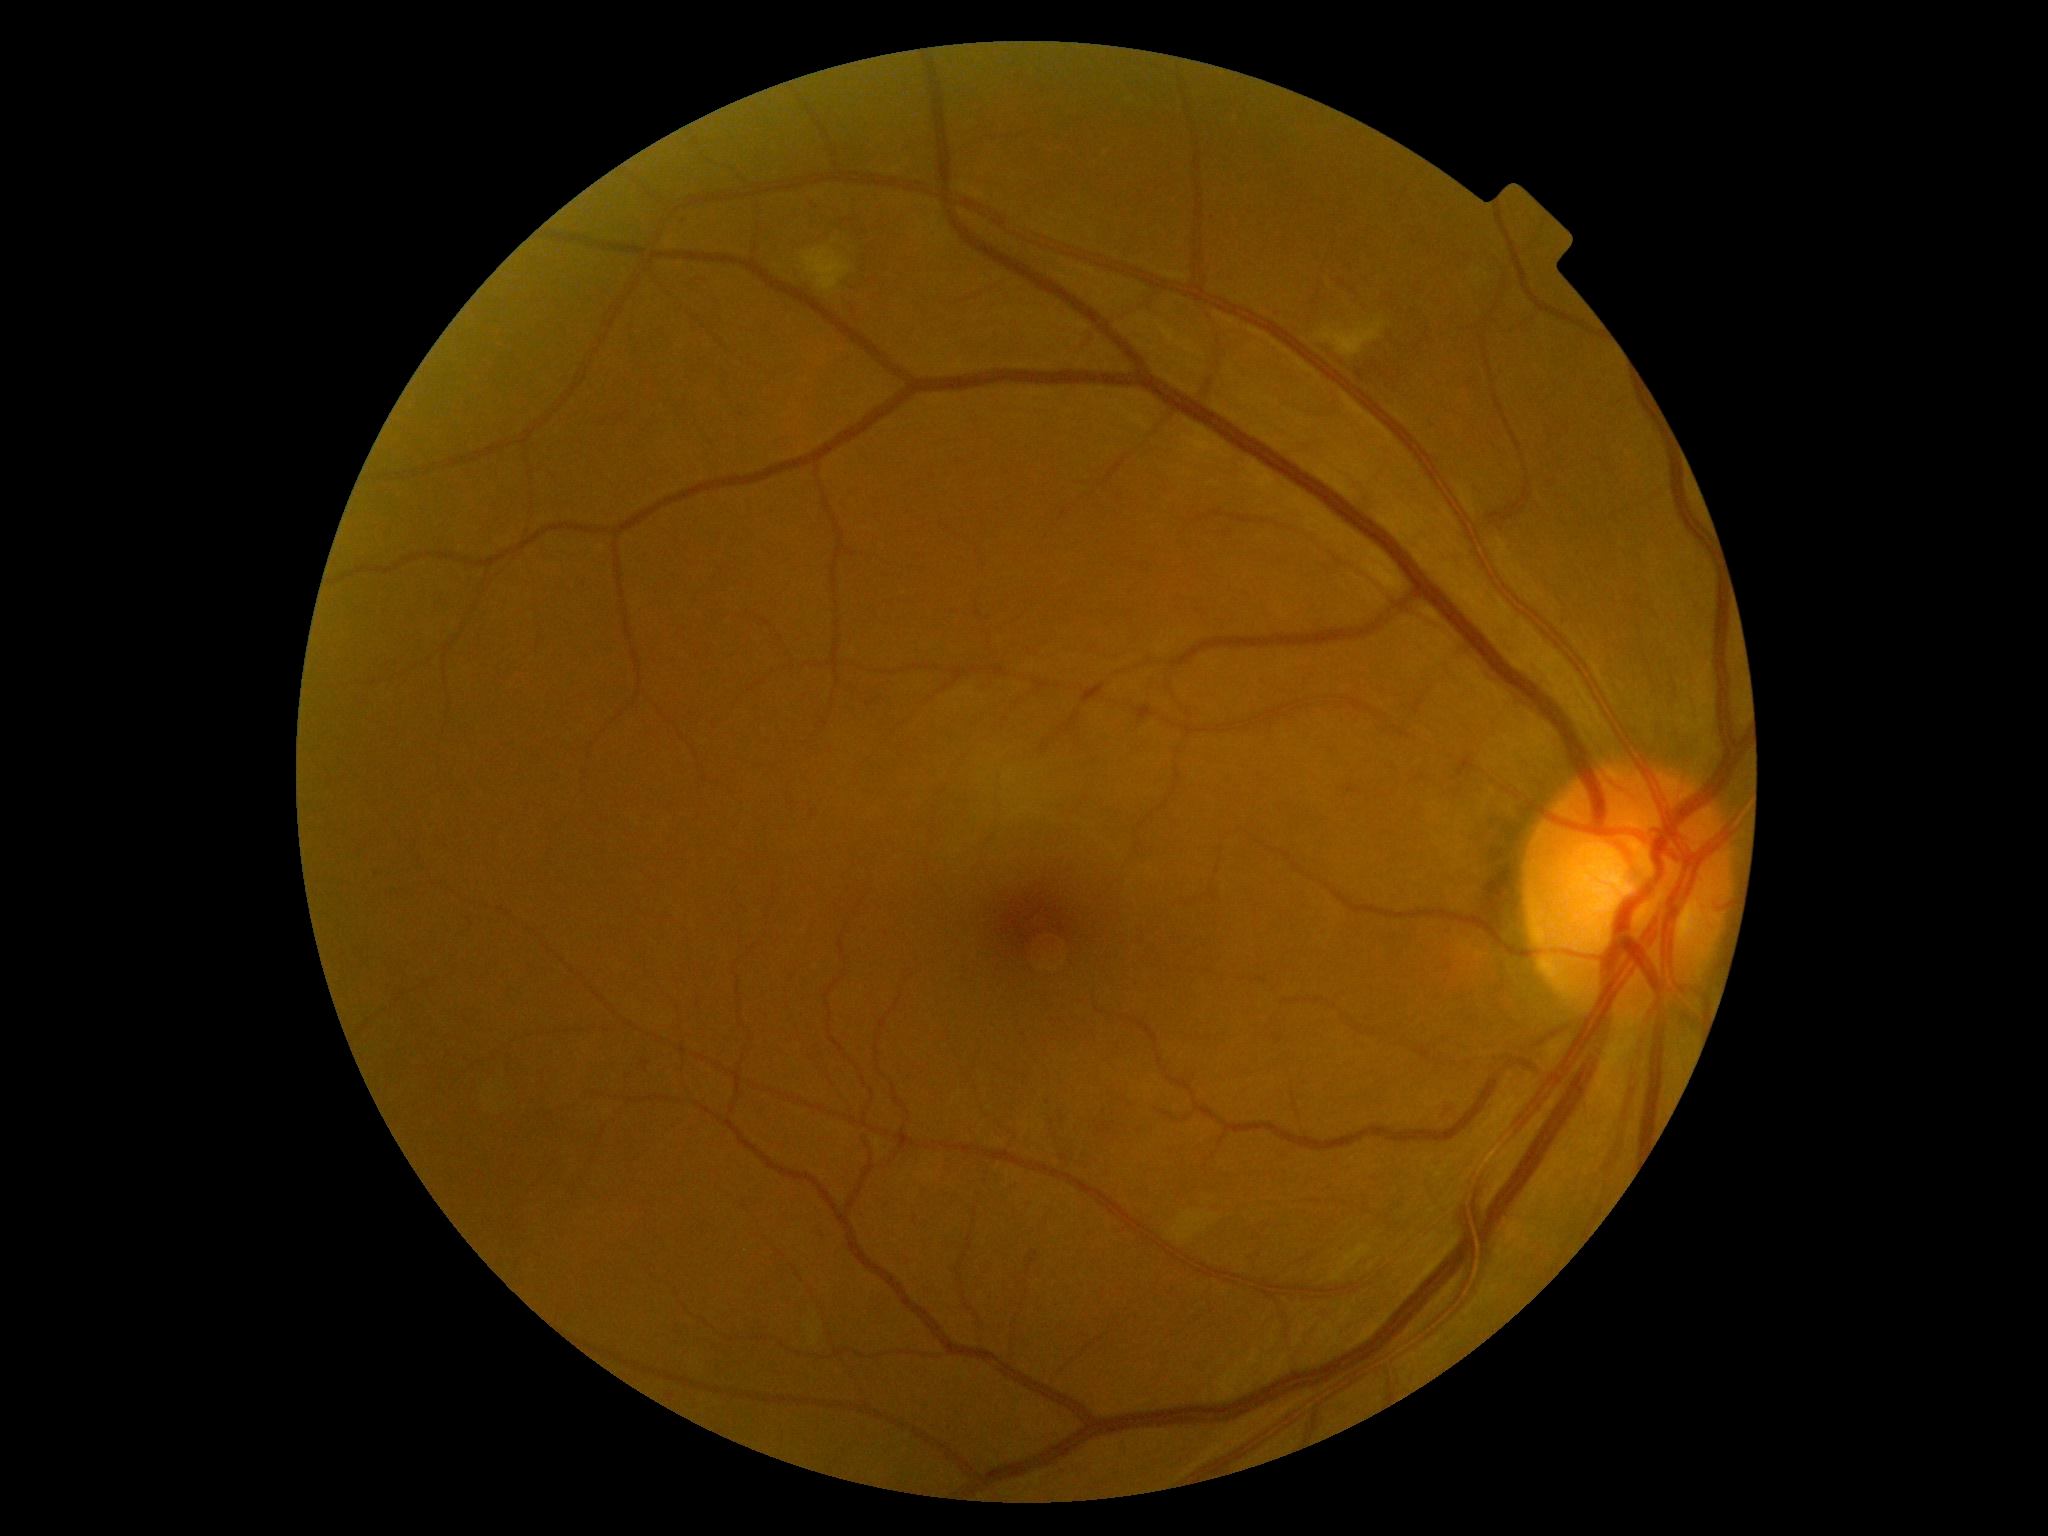
DR severity: grade 2 (moderate NPDR) — more than just microaneurysms but less than severe NPDR